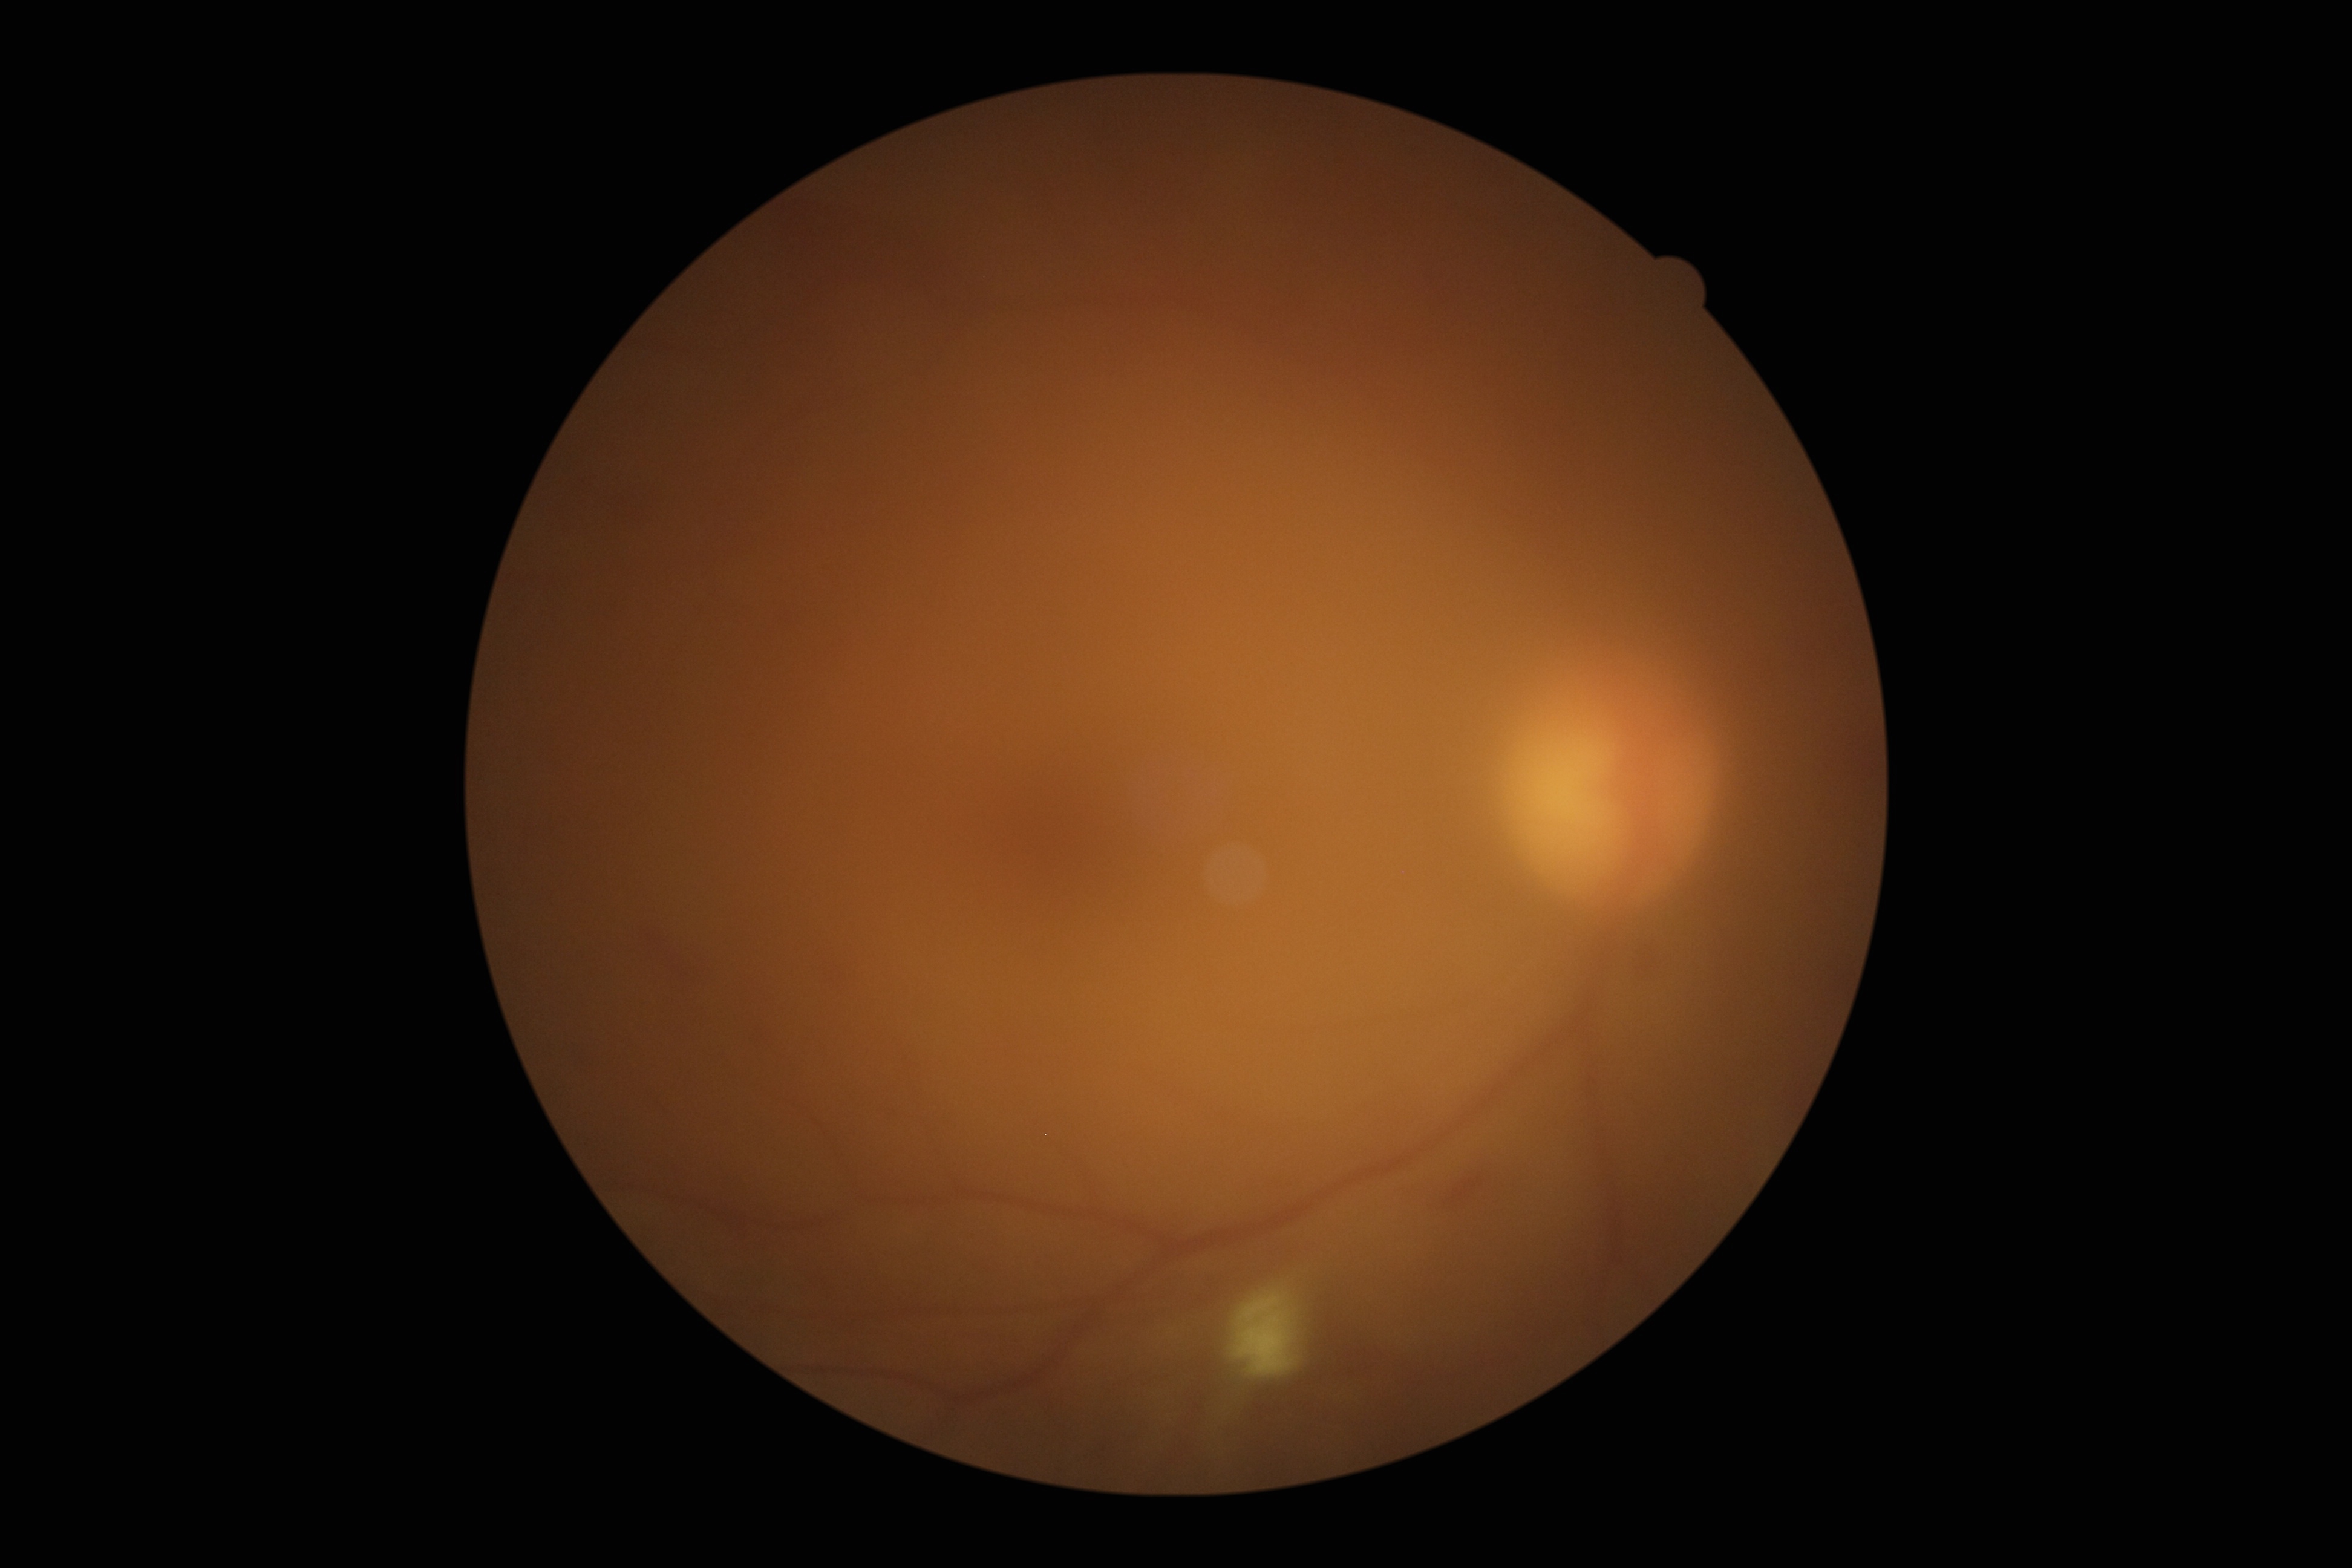
retinopathy grade: moderate non-proliferative diabetic retinopathy (2).